200° field of view; ultra-widefield (UWF) fundus image — 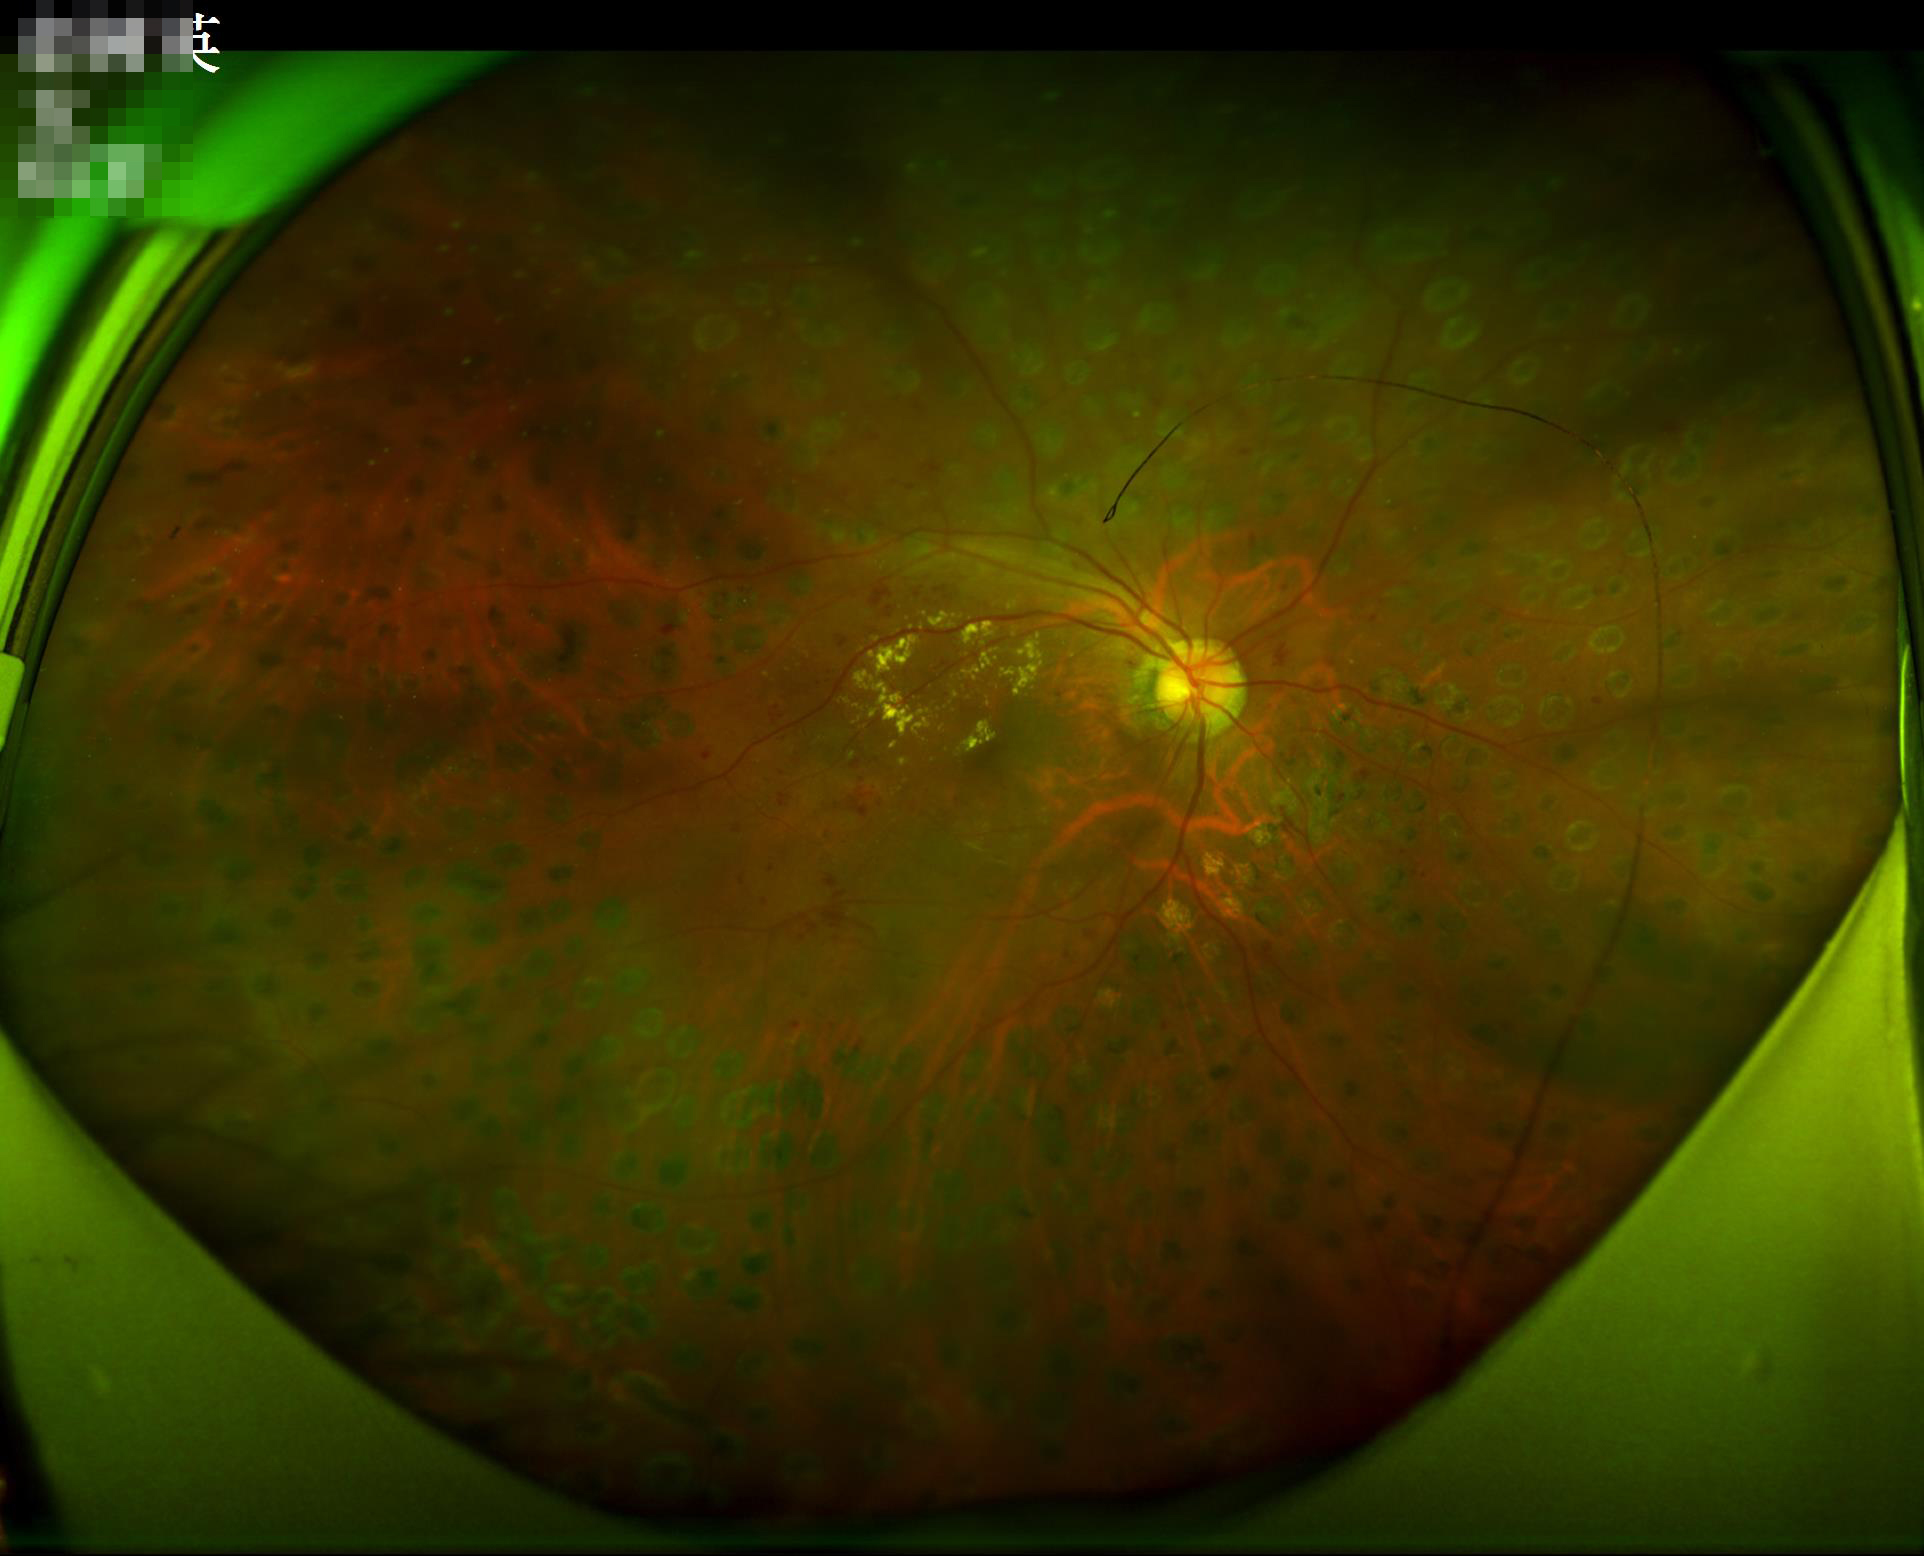

Illumination and color are suboptimal.
Overall quality is good and the image is gradable.